Wide-field fundus image from infant ROP screening: 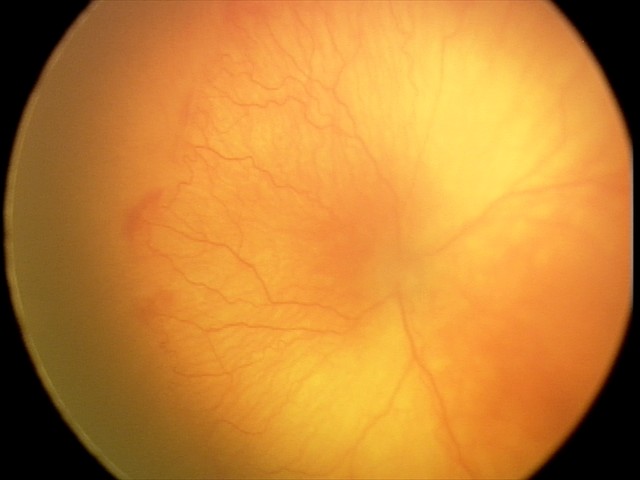
Q: Is plus disease present?
A: plus disease
Q: What was the screening finding?
A: A-ROP (aggressive ROP) — rapidly progressive severe ROP with prominent plus disease, often without classic stage progression